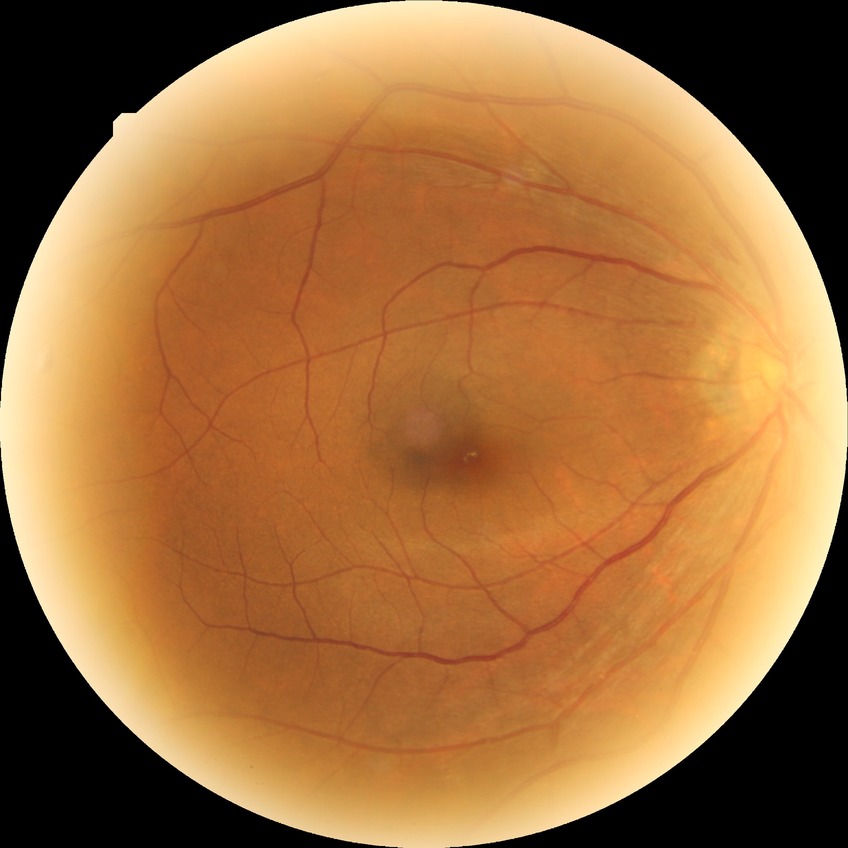 Modified Davis grade: SDR.